848x848px. 45-degree field of view. NIDEK AFC-230 fundus camera. Color fundus image. Nonmydriatic: 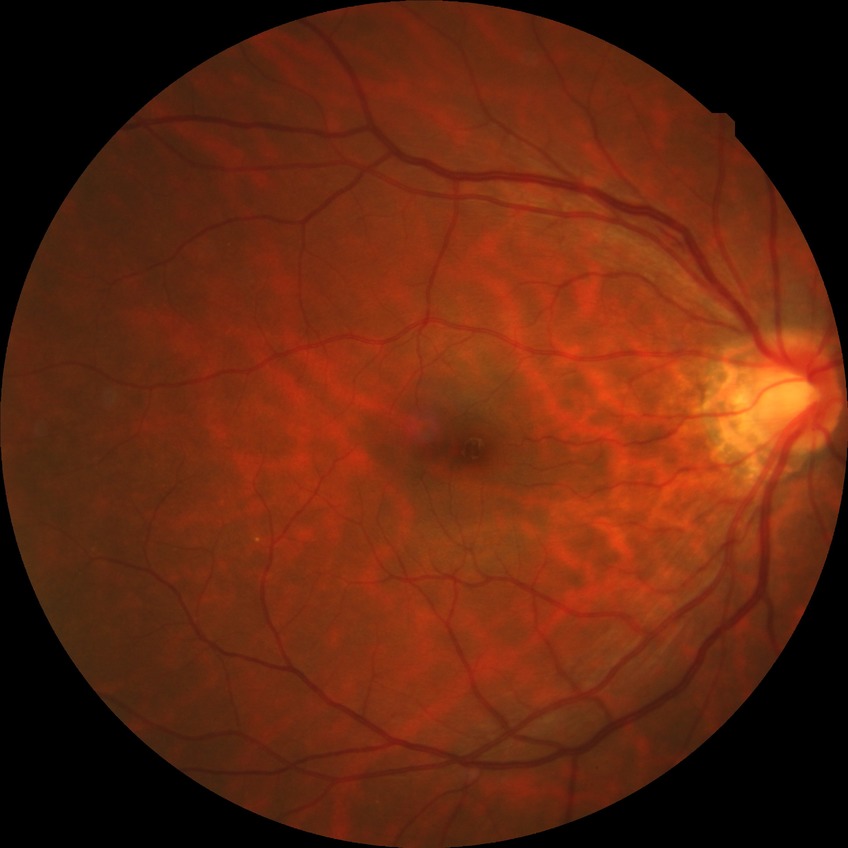
  davis_grade: no diabetic retinopathy